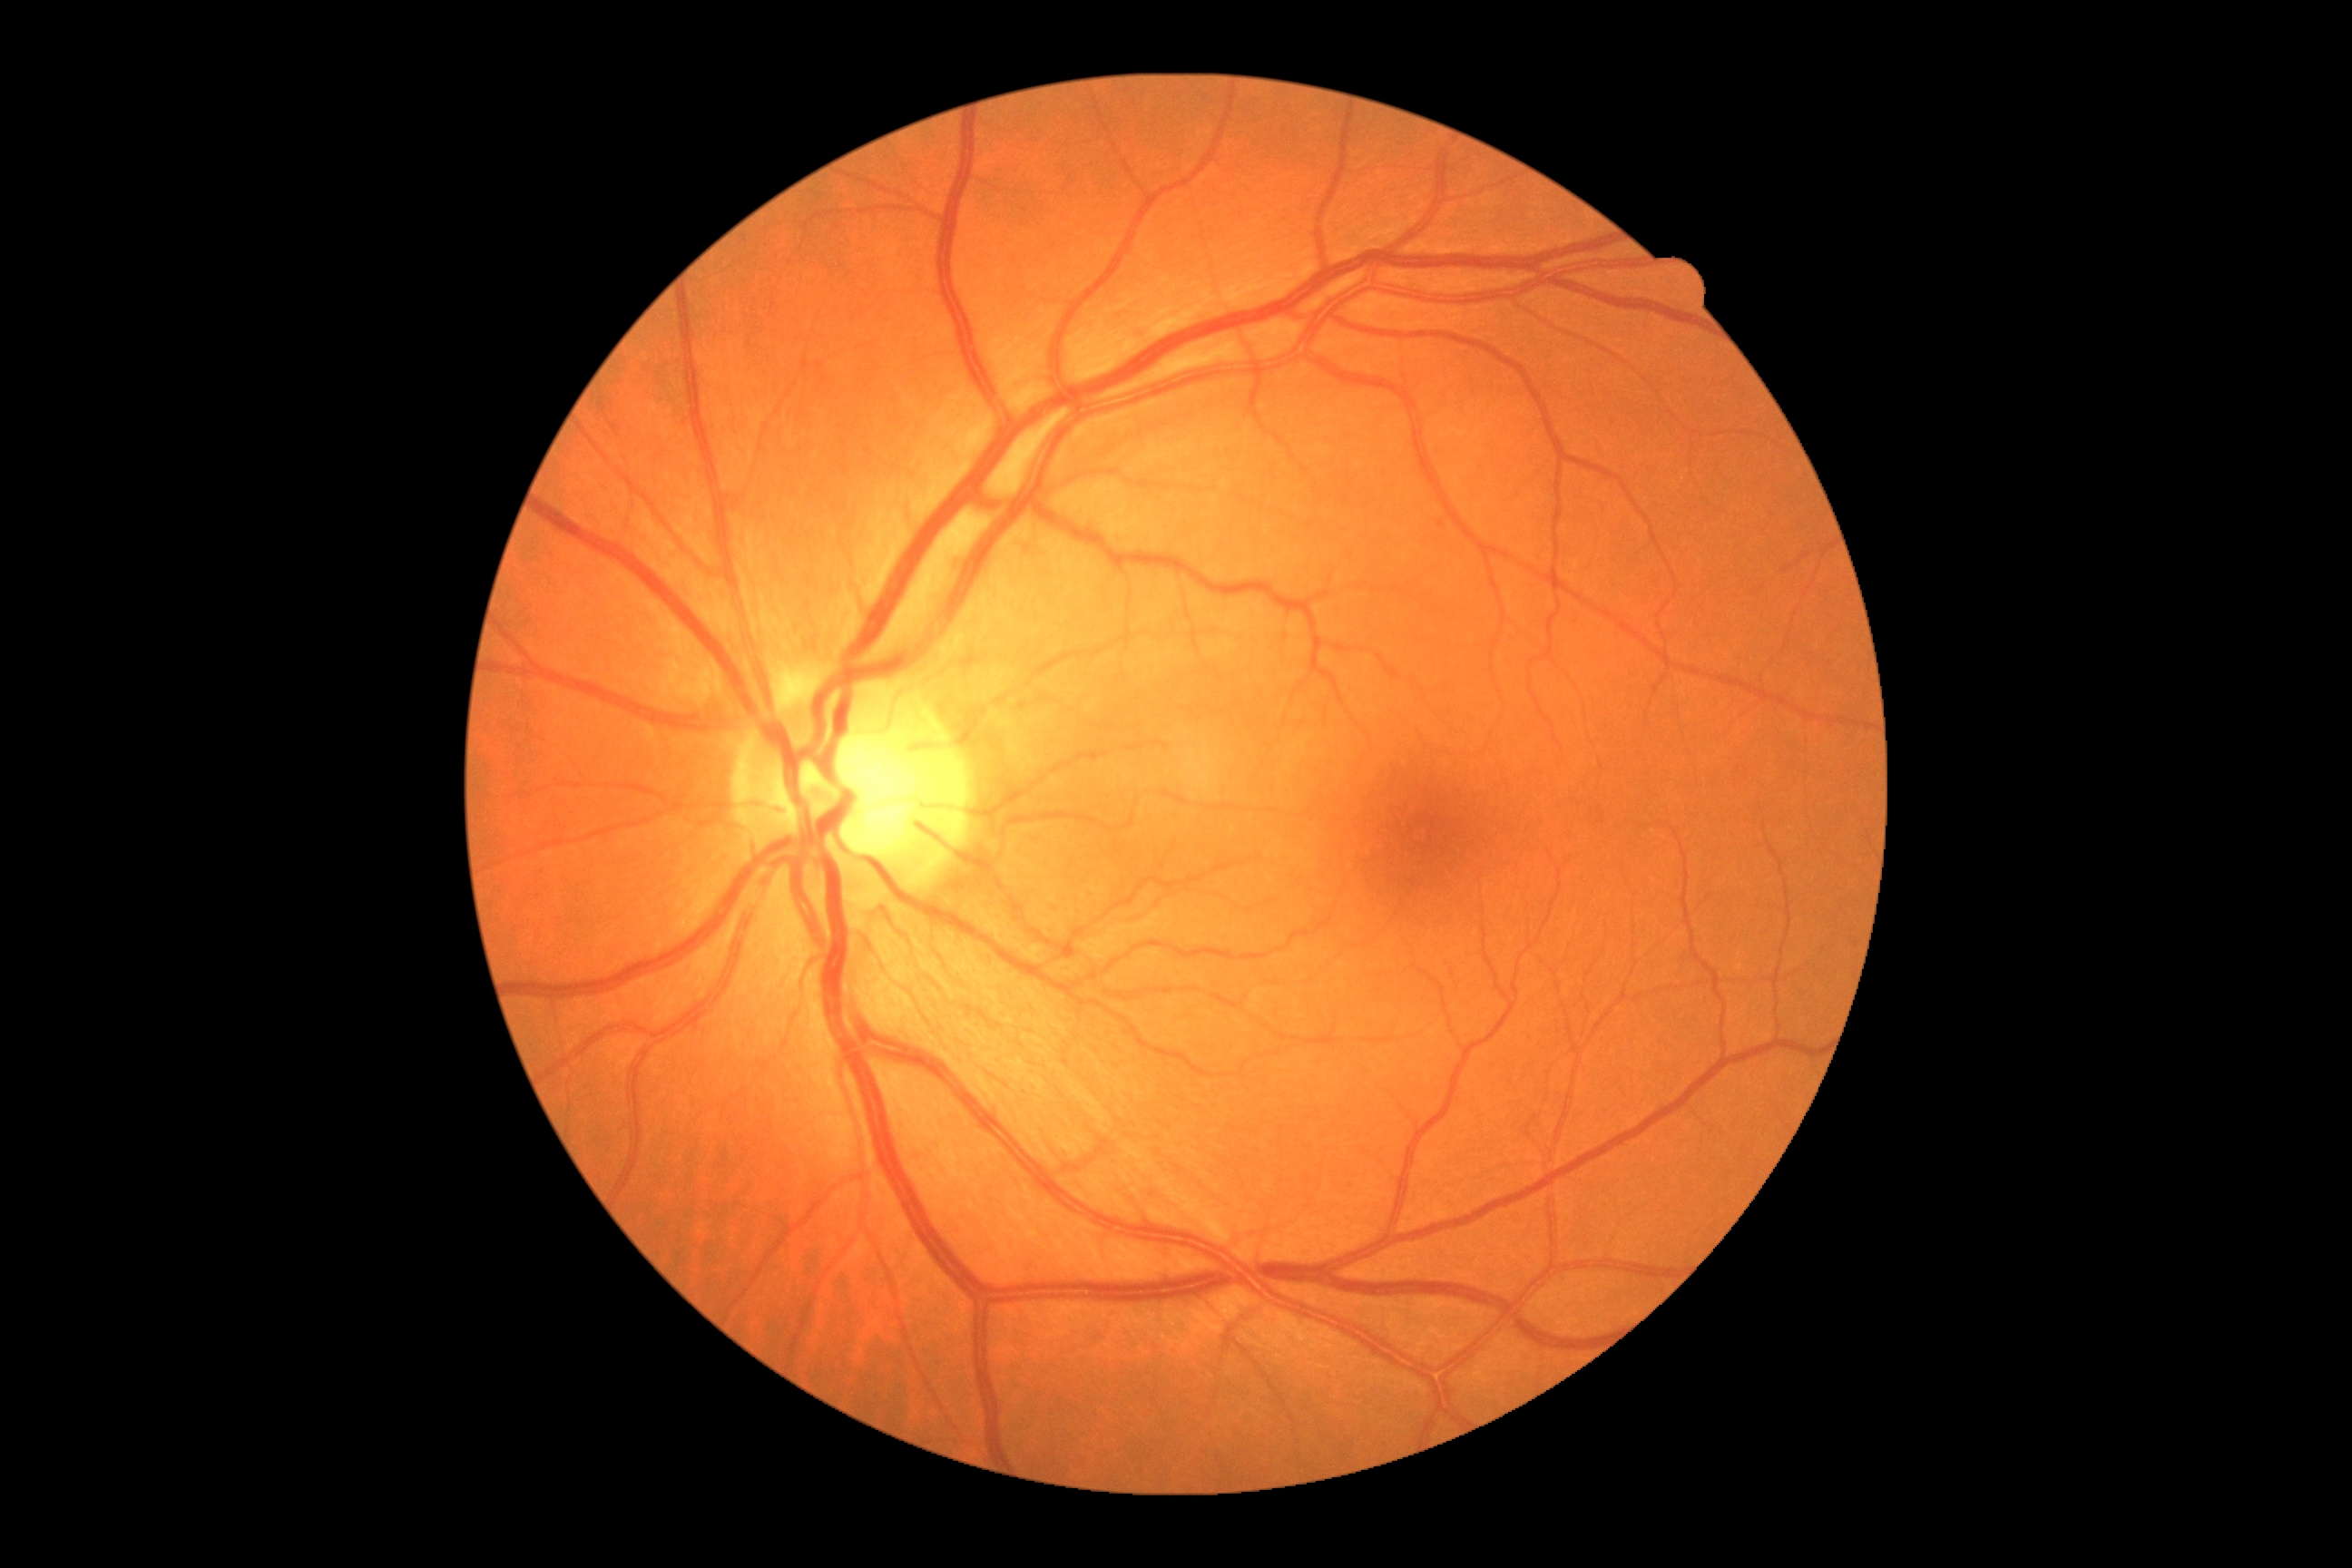
Diabetic retinopathy (DR): no apparent retinopathy (grade 0).